CFP
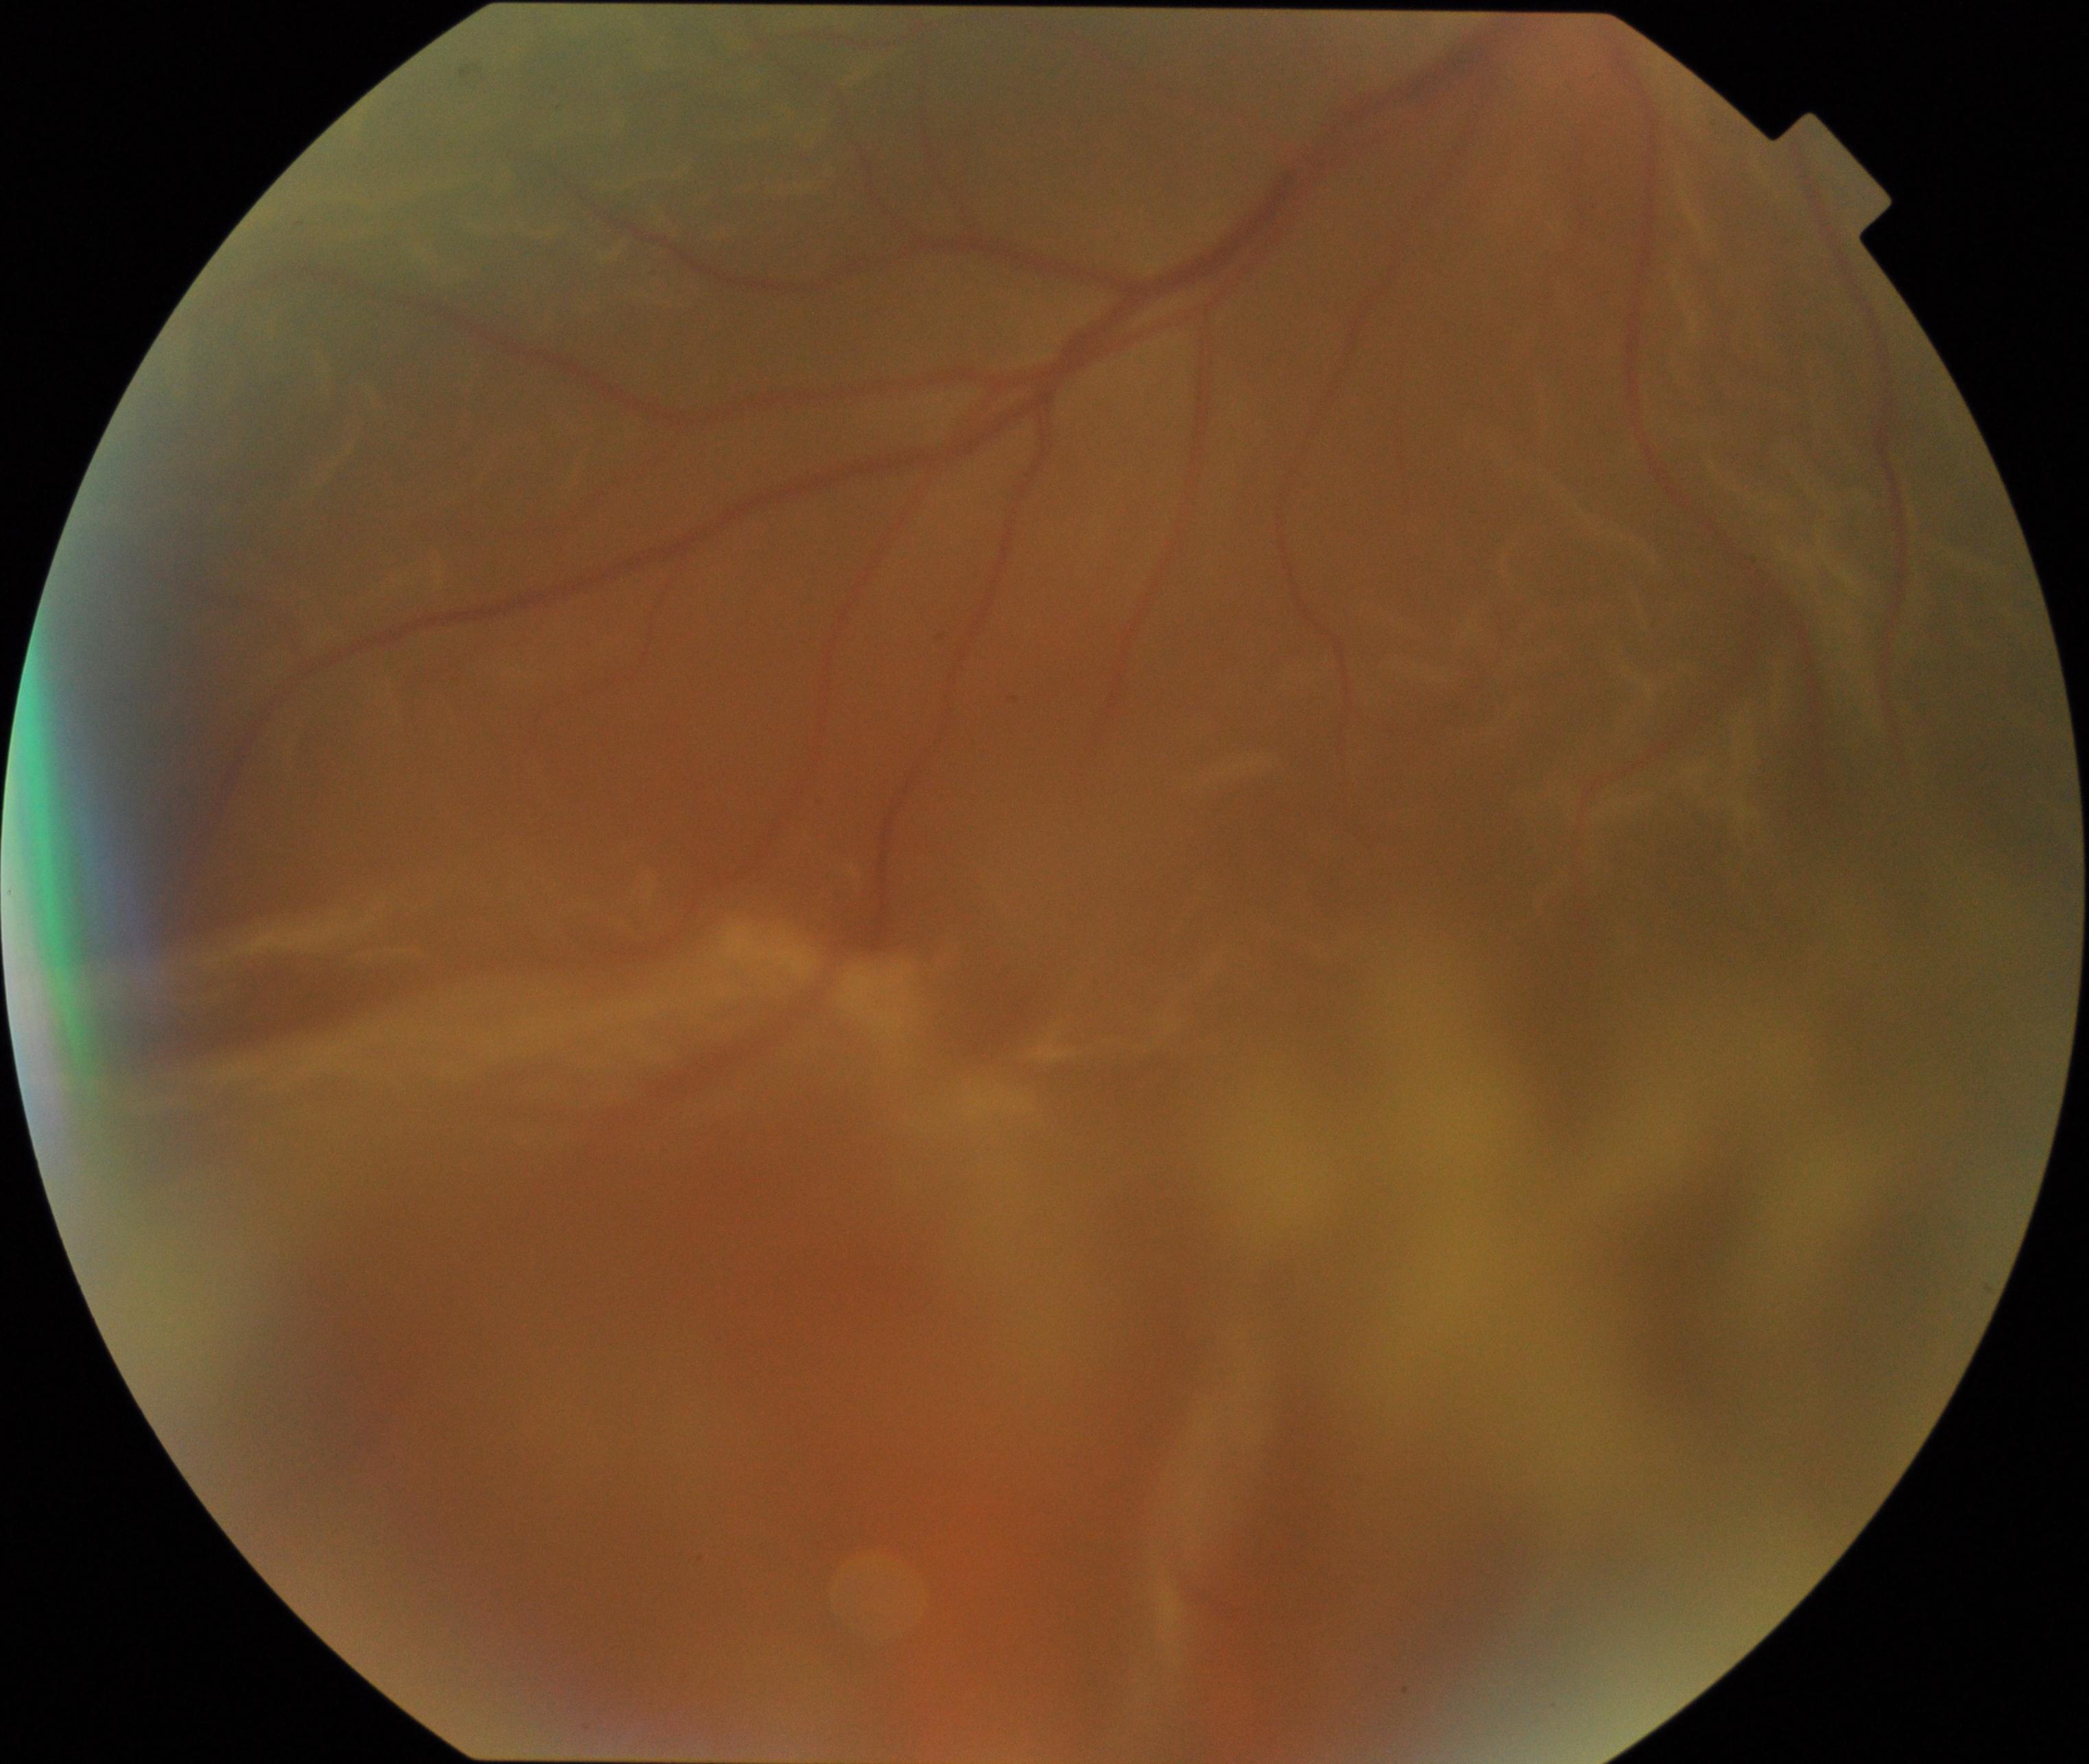

Consistent with rhegmatogenous retinal detachment.